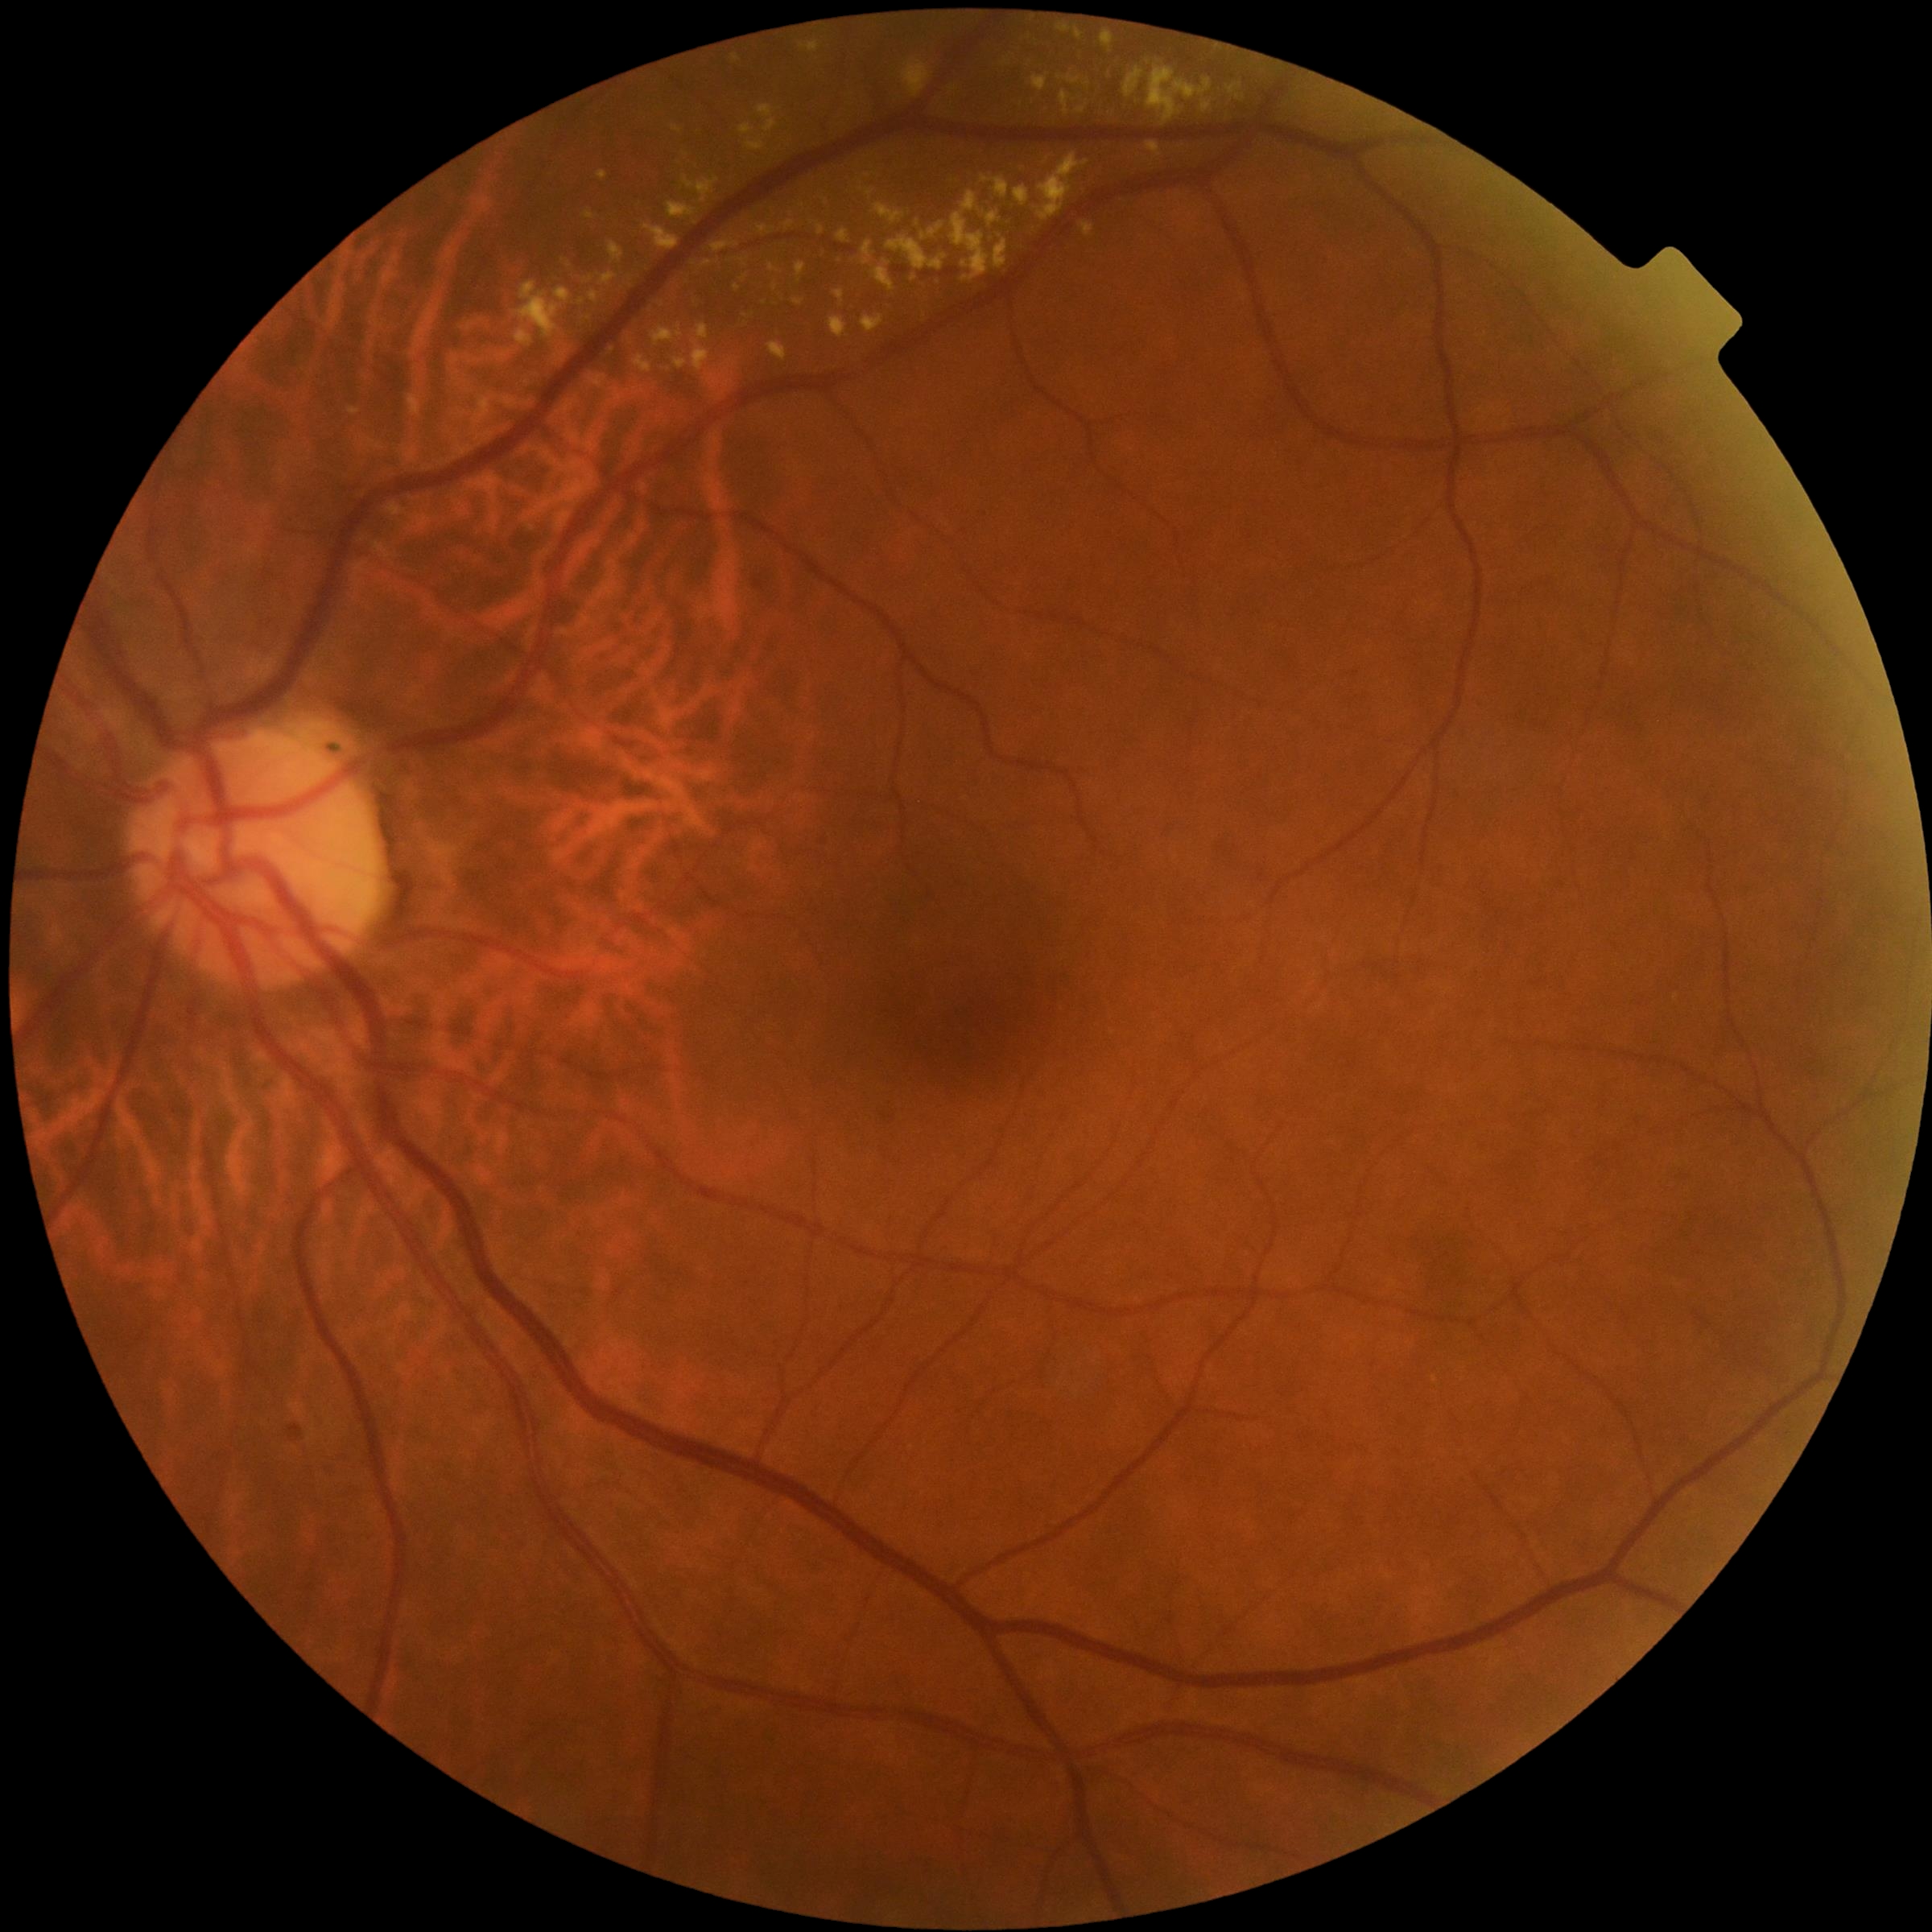

{"partial":true,"dr_grade":2,"dr_grade_name":"moderate NPDR","lesions":{"se":null,"ma":null,"ex":[[800,41,820,54],[837,230,851,244],[862,242,875,266],[559,353,567,358],[903,60,931,99],[672,126,682,133],[727,360,736,365],[702,261,713,268],[1123,67,1146,99],[667,202,696,219],[836,291,845,306],[950,191,1003,281],[916,221,920,229],[599,274,617,287],[1061,92,1076,116],[1076,105,1088,114]],"ex_small_centers":[[862,191]],"he":null}}